Acquired on the Clarity RetCam 3 · wide-field fundus photograph from neonatal ROP screening — 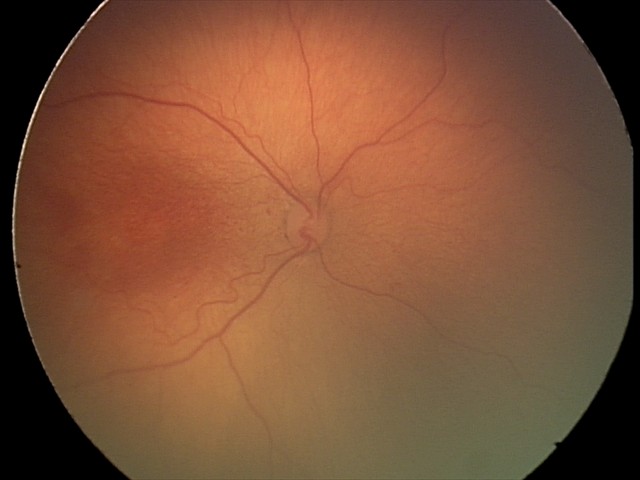

Diagnosis from this screening exam: retinopathy of prematurity (ROP) stage 2.
No plus disease.